DR severity per modified Davis staging: 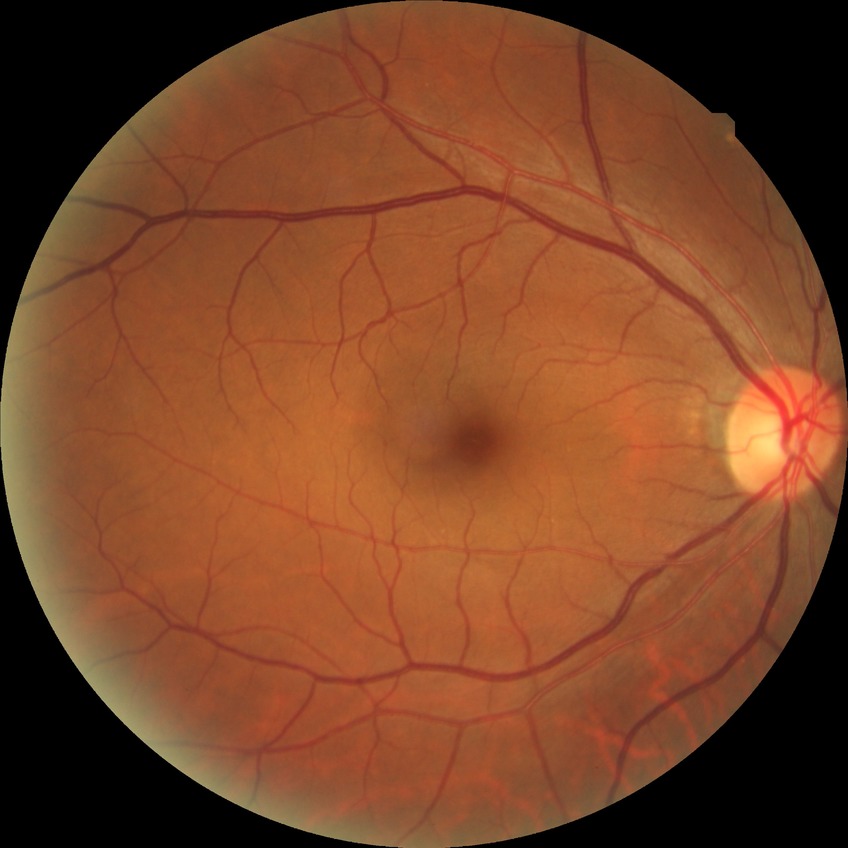

Diabetic retinopathy (DR) is no diabetic retinopathy (NDR).